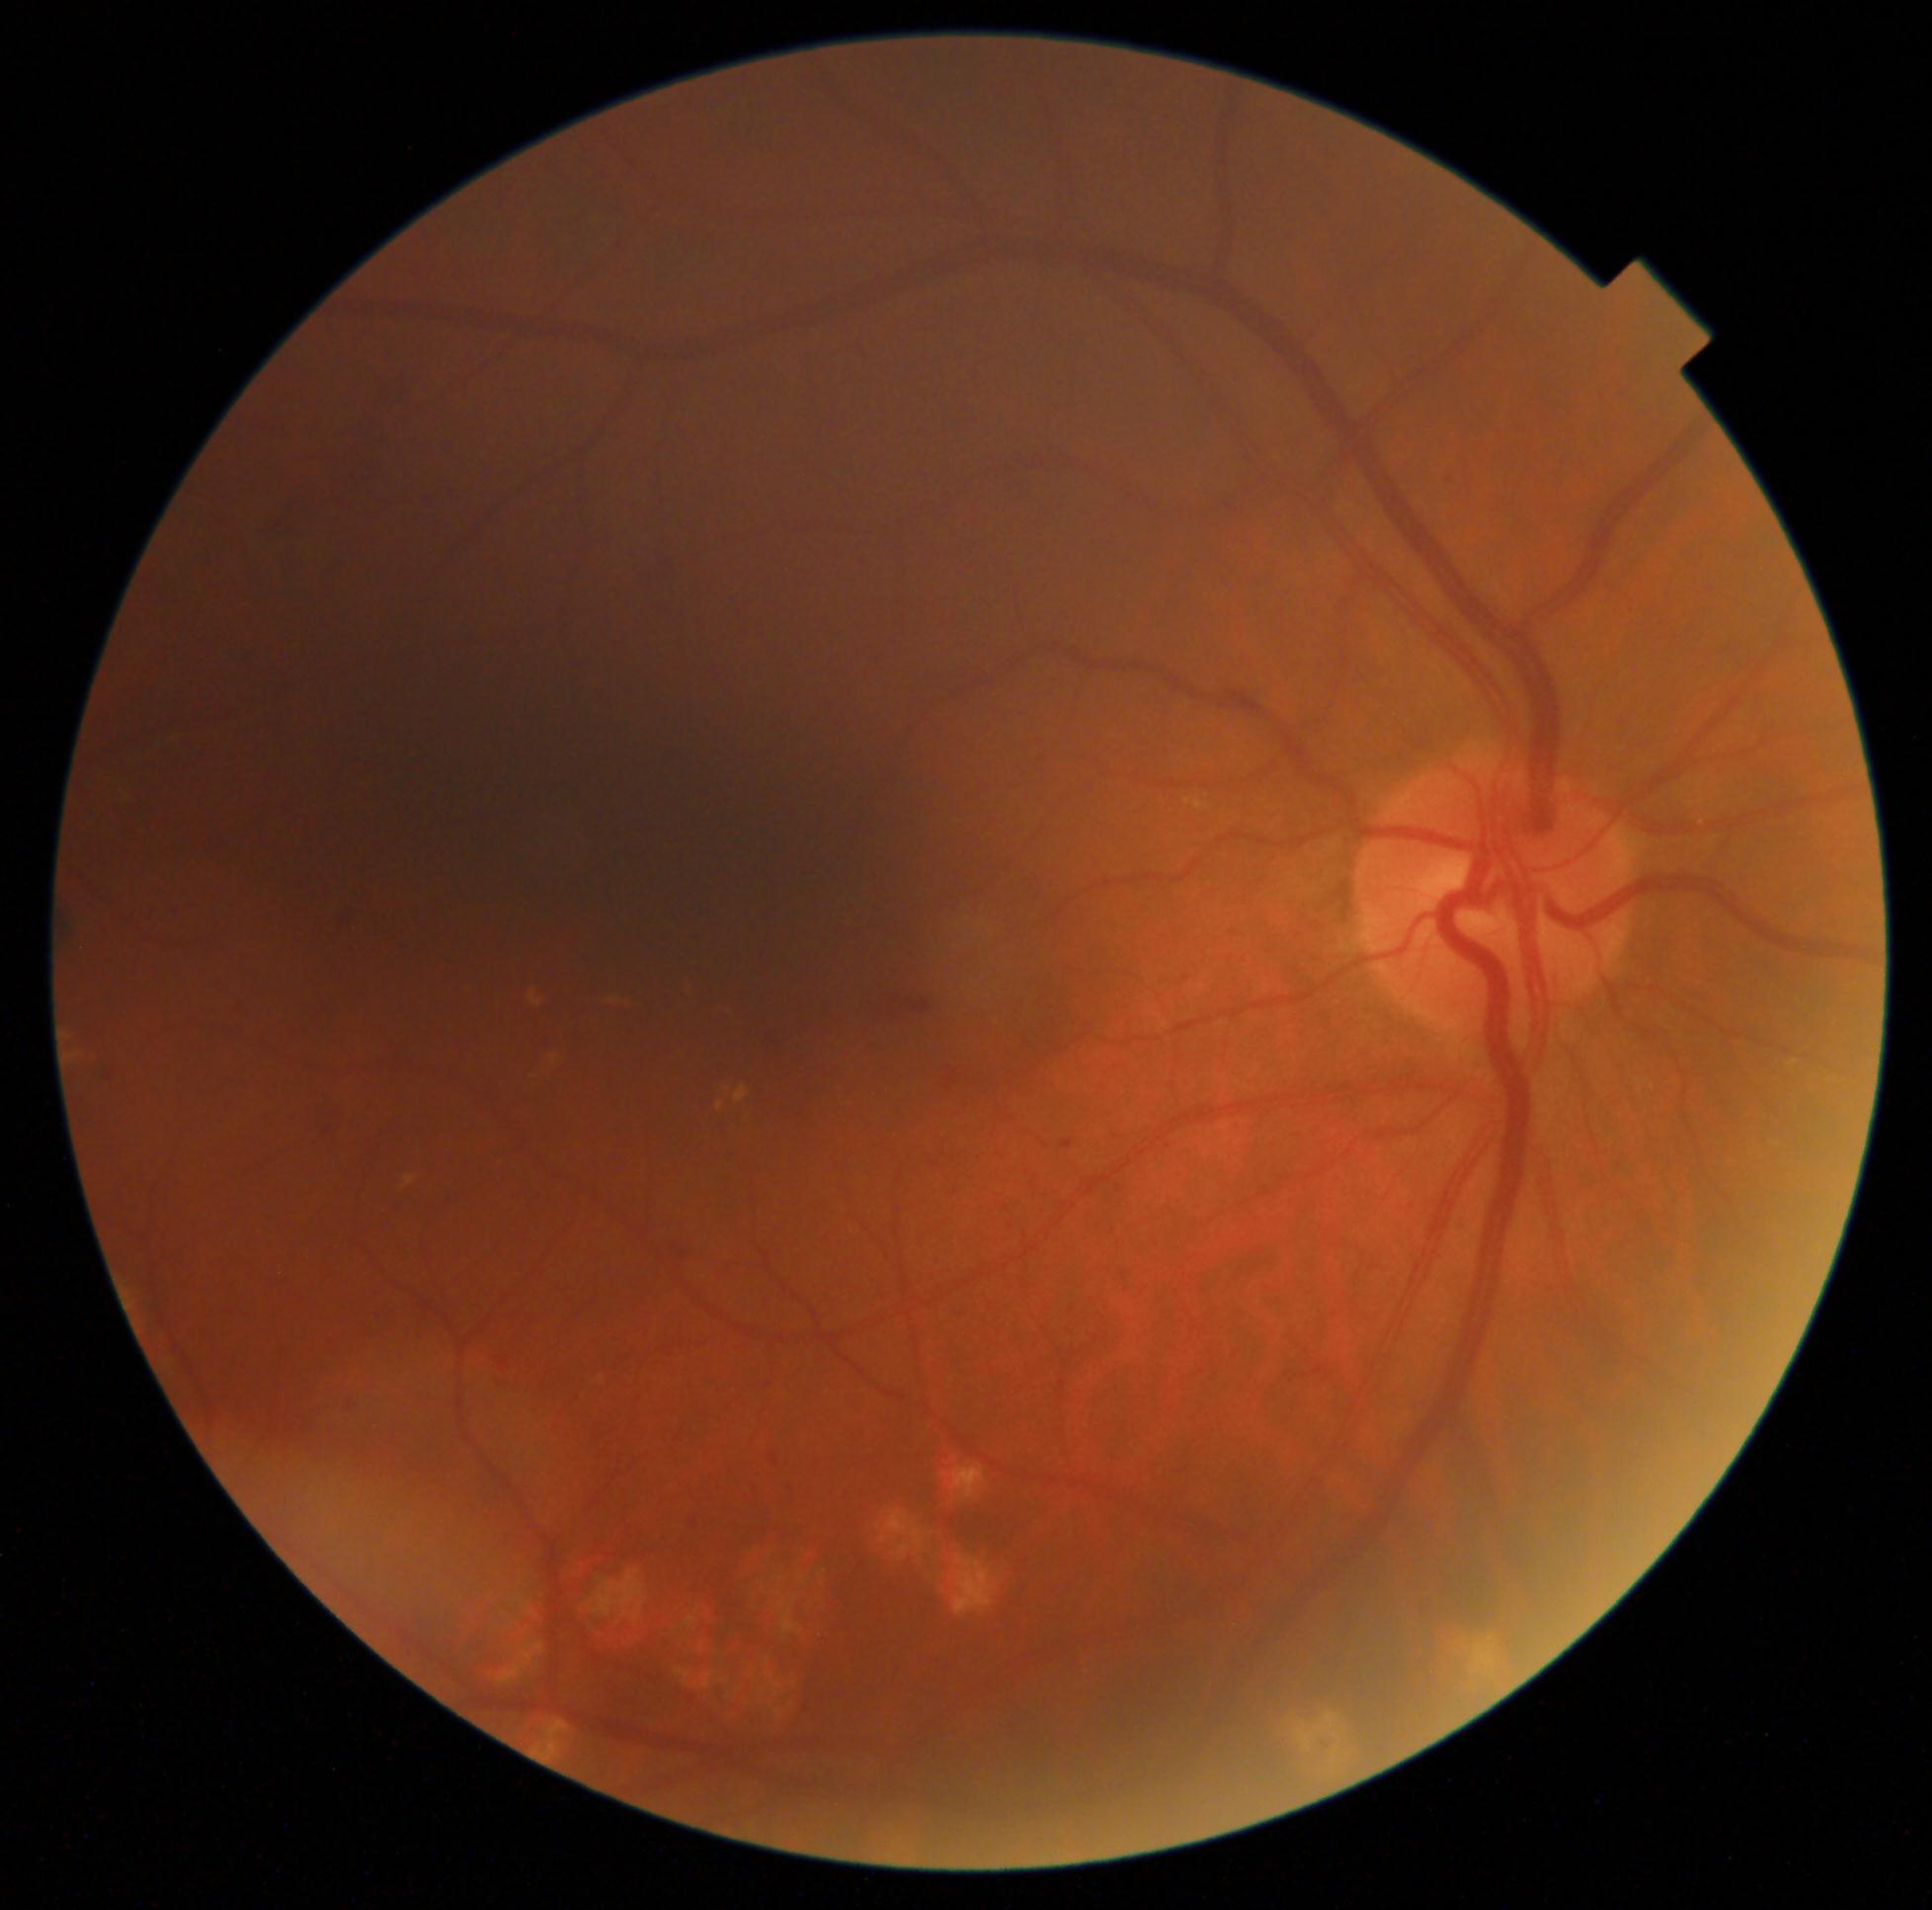

Disease class: non-proliferative diabetic retinopathy. DR grade is 2.